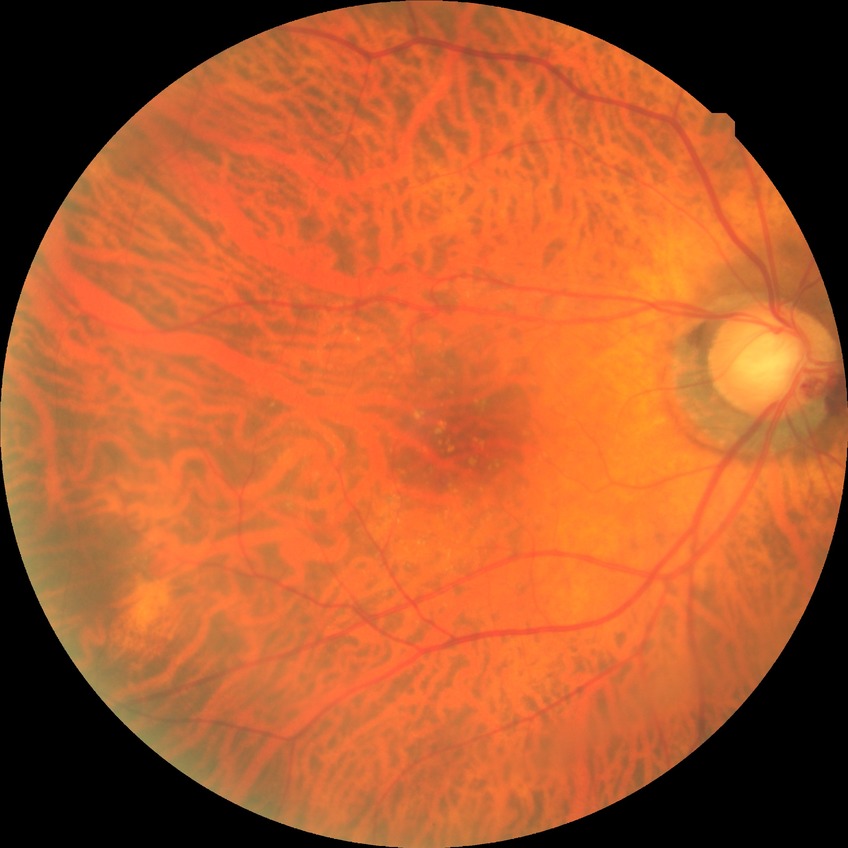 retinopathy stage = no diabetic retinopathy